Pupil-dilated; FOV: 50 degrees; 1932 by 1932 pixels:
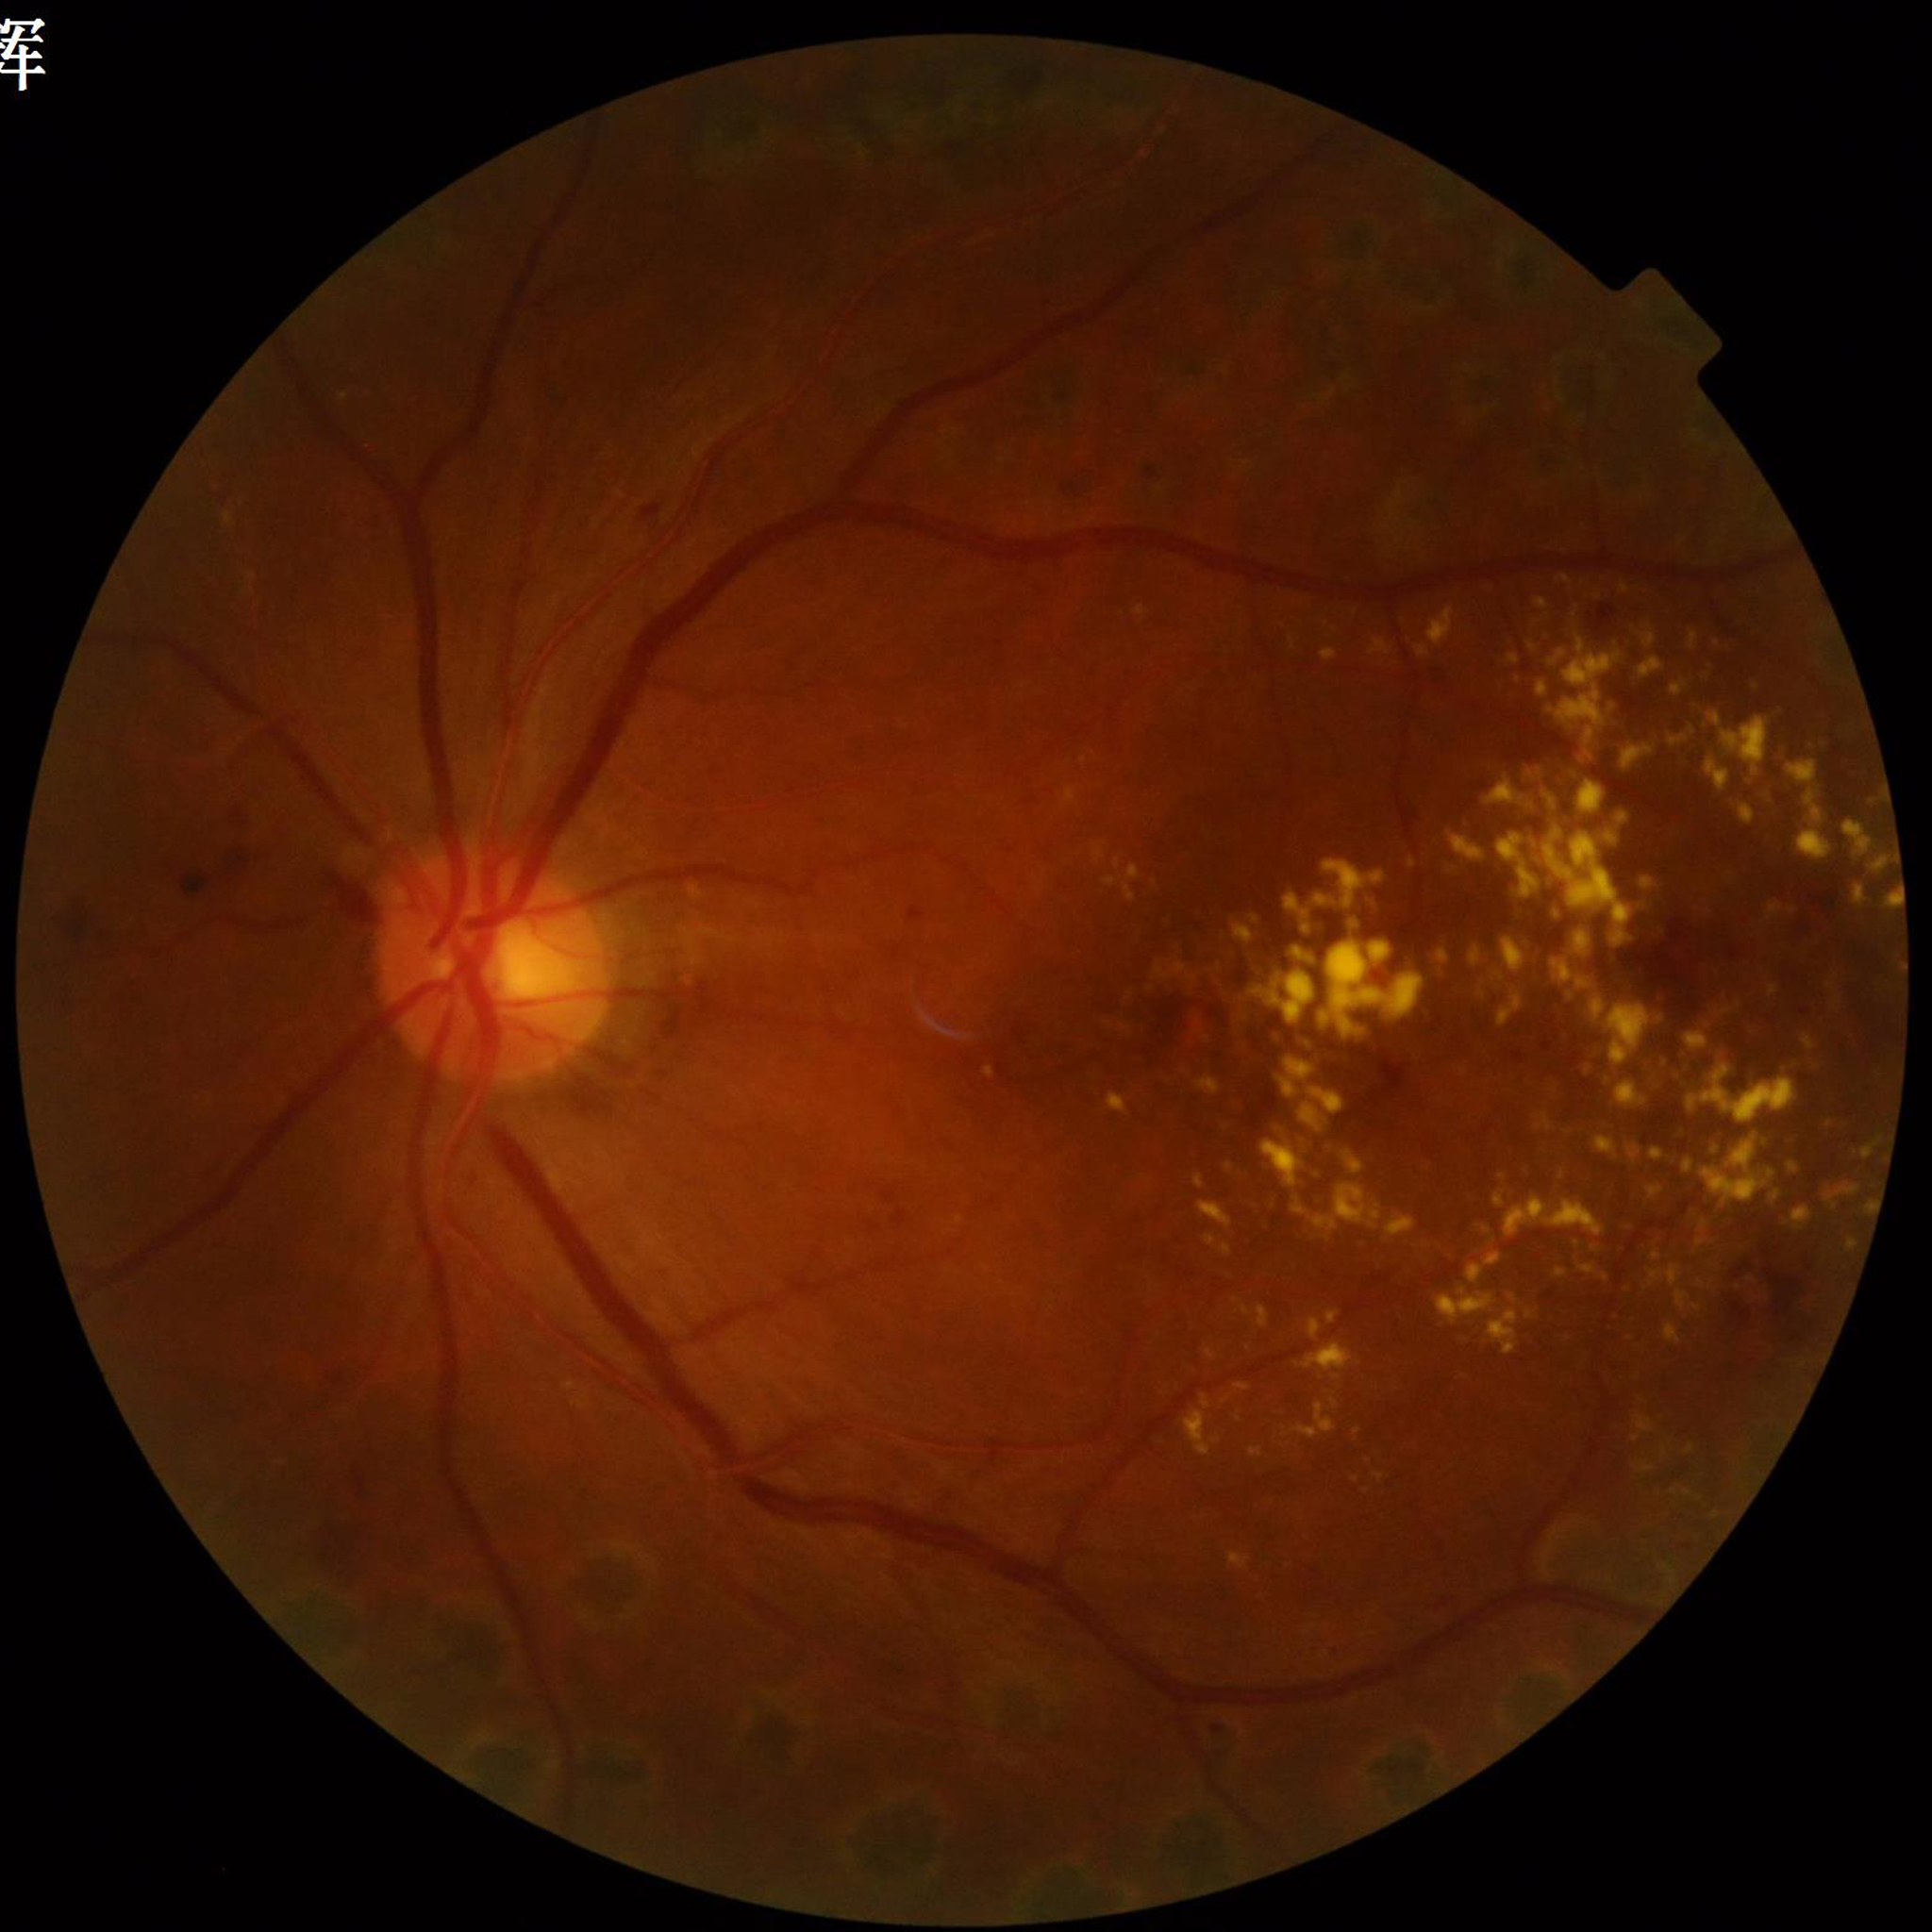

Quality assessment: adequate.
Retinal fundus photograph from a patient with diabetic retinopathy (DR).